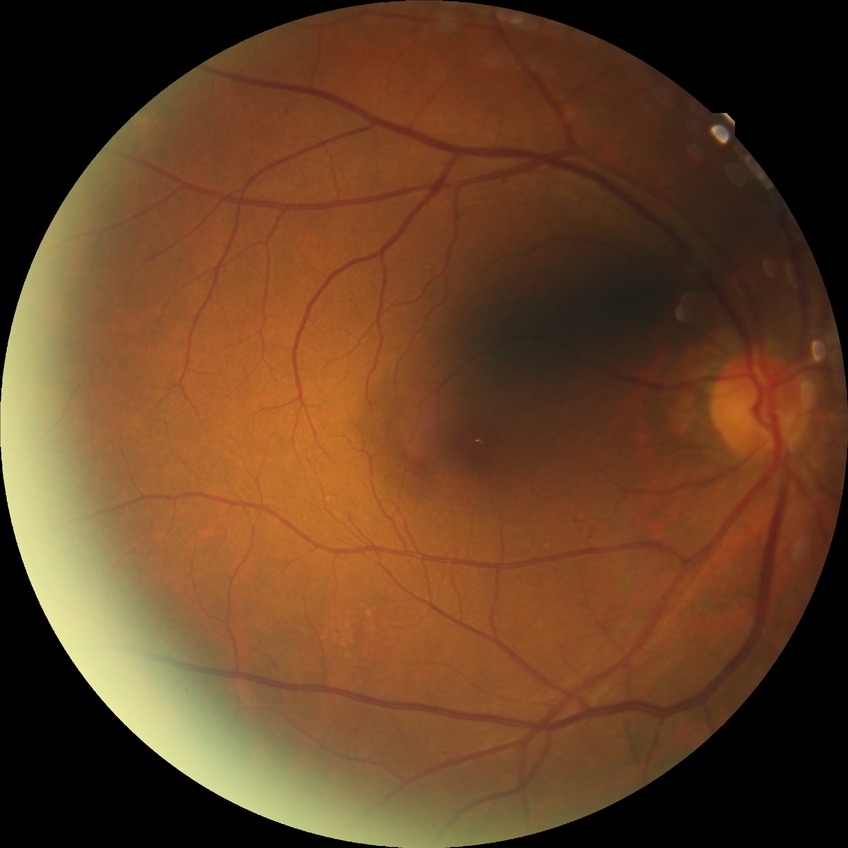
diabetic retinopathy severity=no diabetic retinopathy.